Retinal fundus photograph
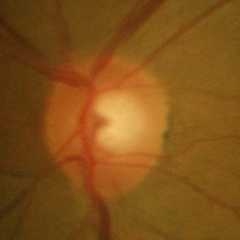 Findings consistent with no glaucomatous changes.